Color fundus image.
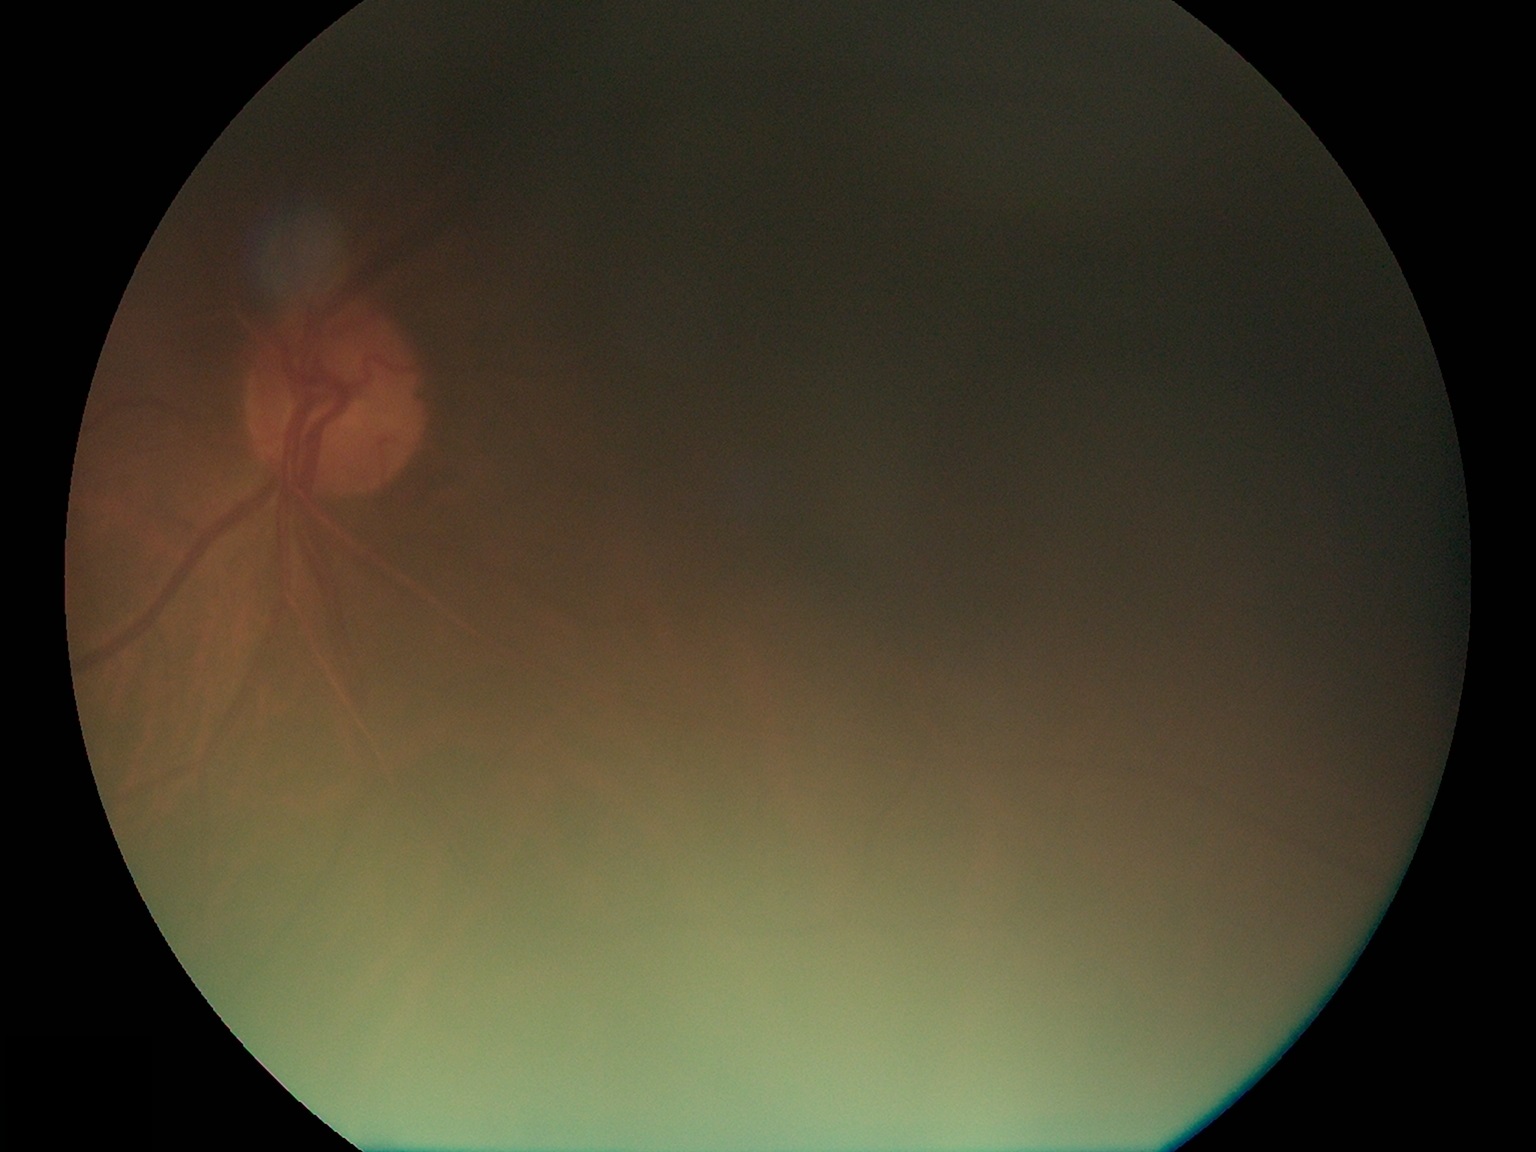
Retinopathy grade is ungradable due to poor image quality.